NIDEK AFC-230. Posterior pole photograph. 848 x 848 pixels. 45 degree fundus photograph.
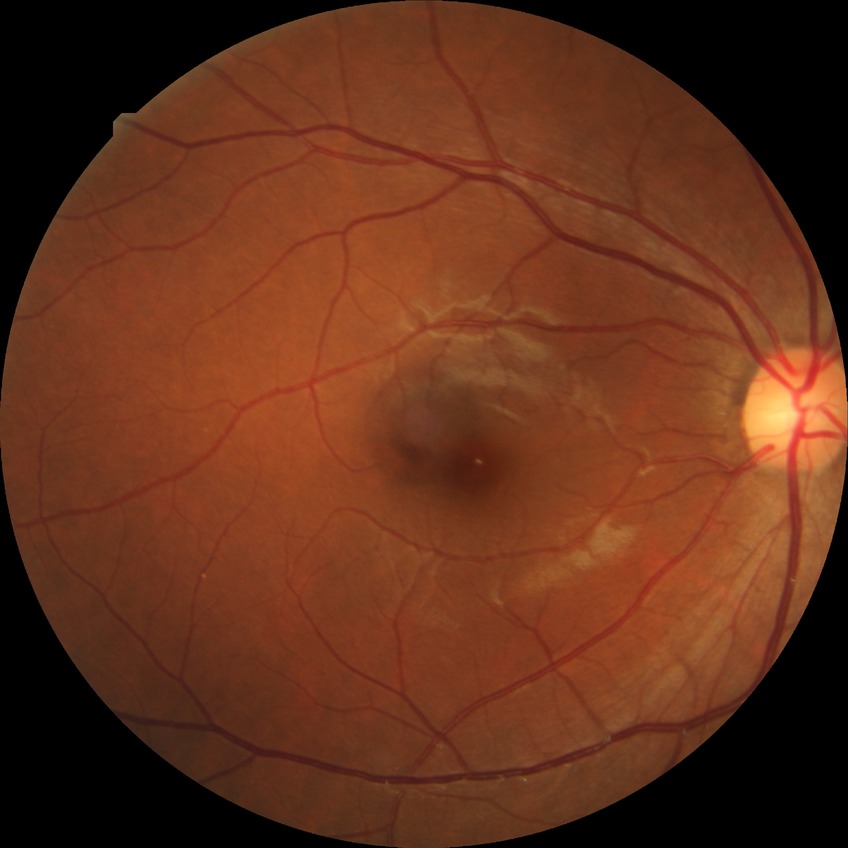

diabetic retinopathy severity = no diabetic retinopathy